848x848px · camera: NIDEK AFC-230: 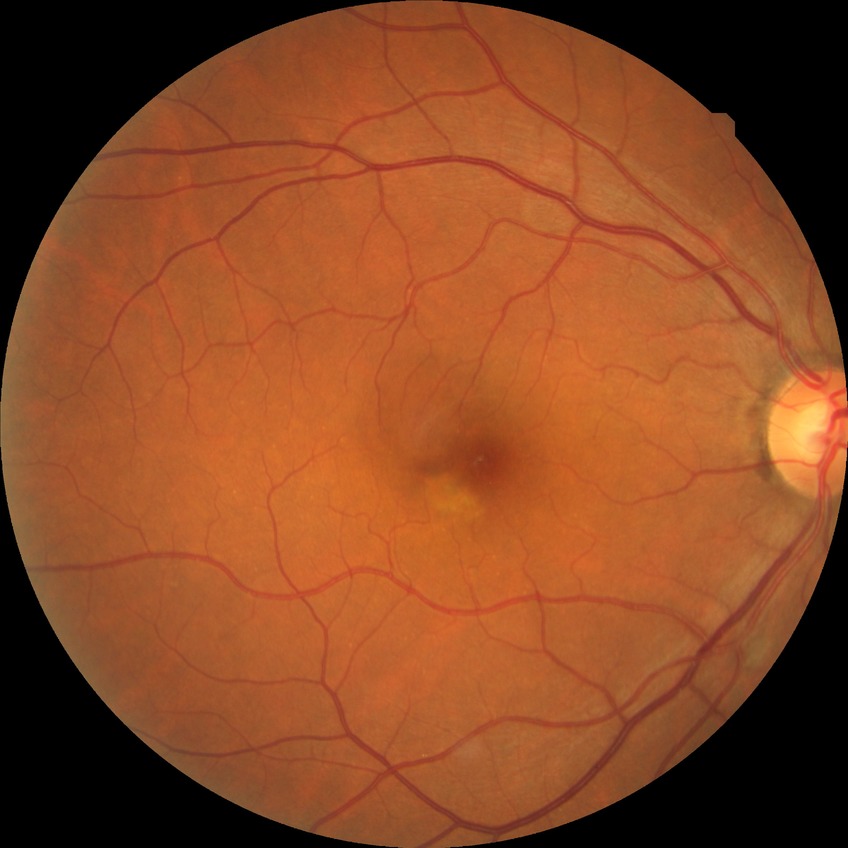

{
  "davis_grade": "no diabetic retinopathy"
}